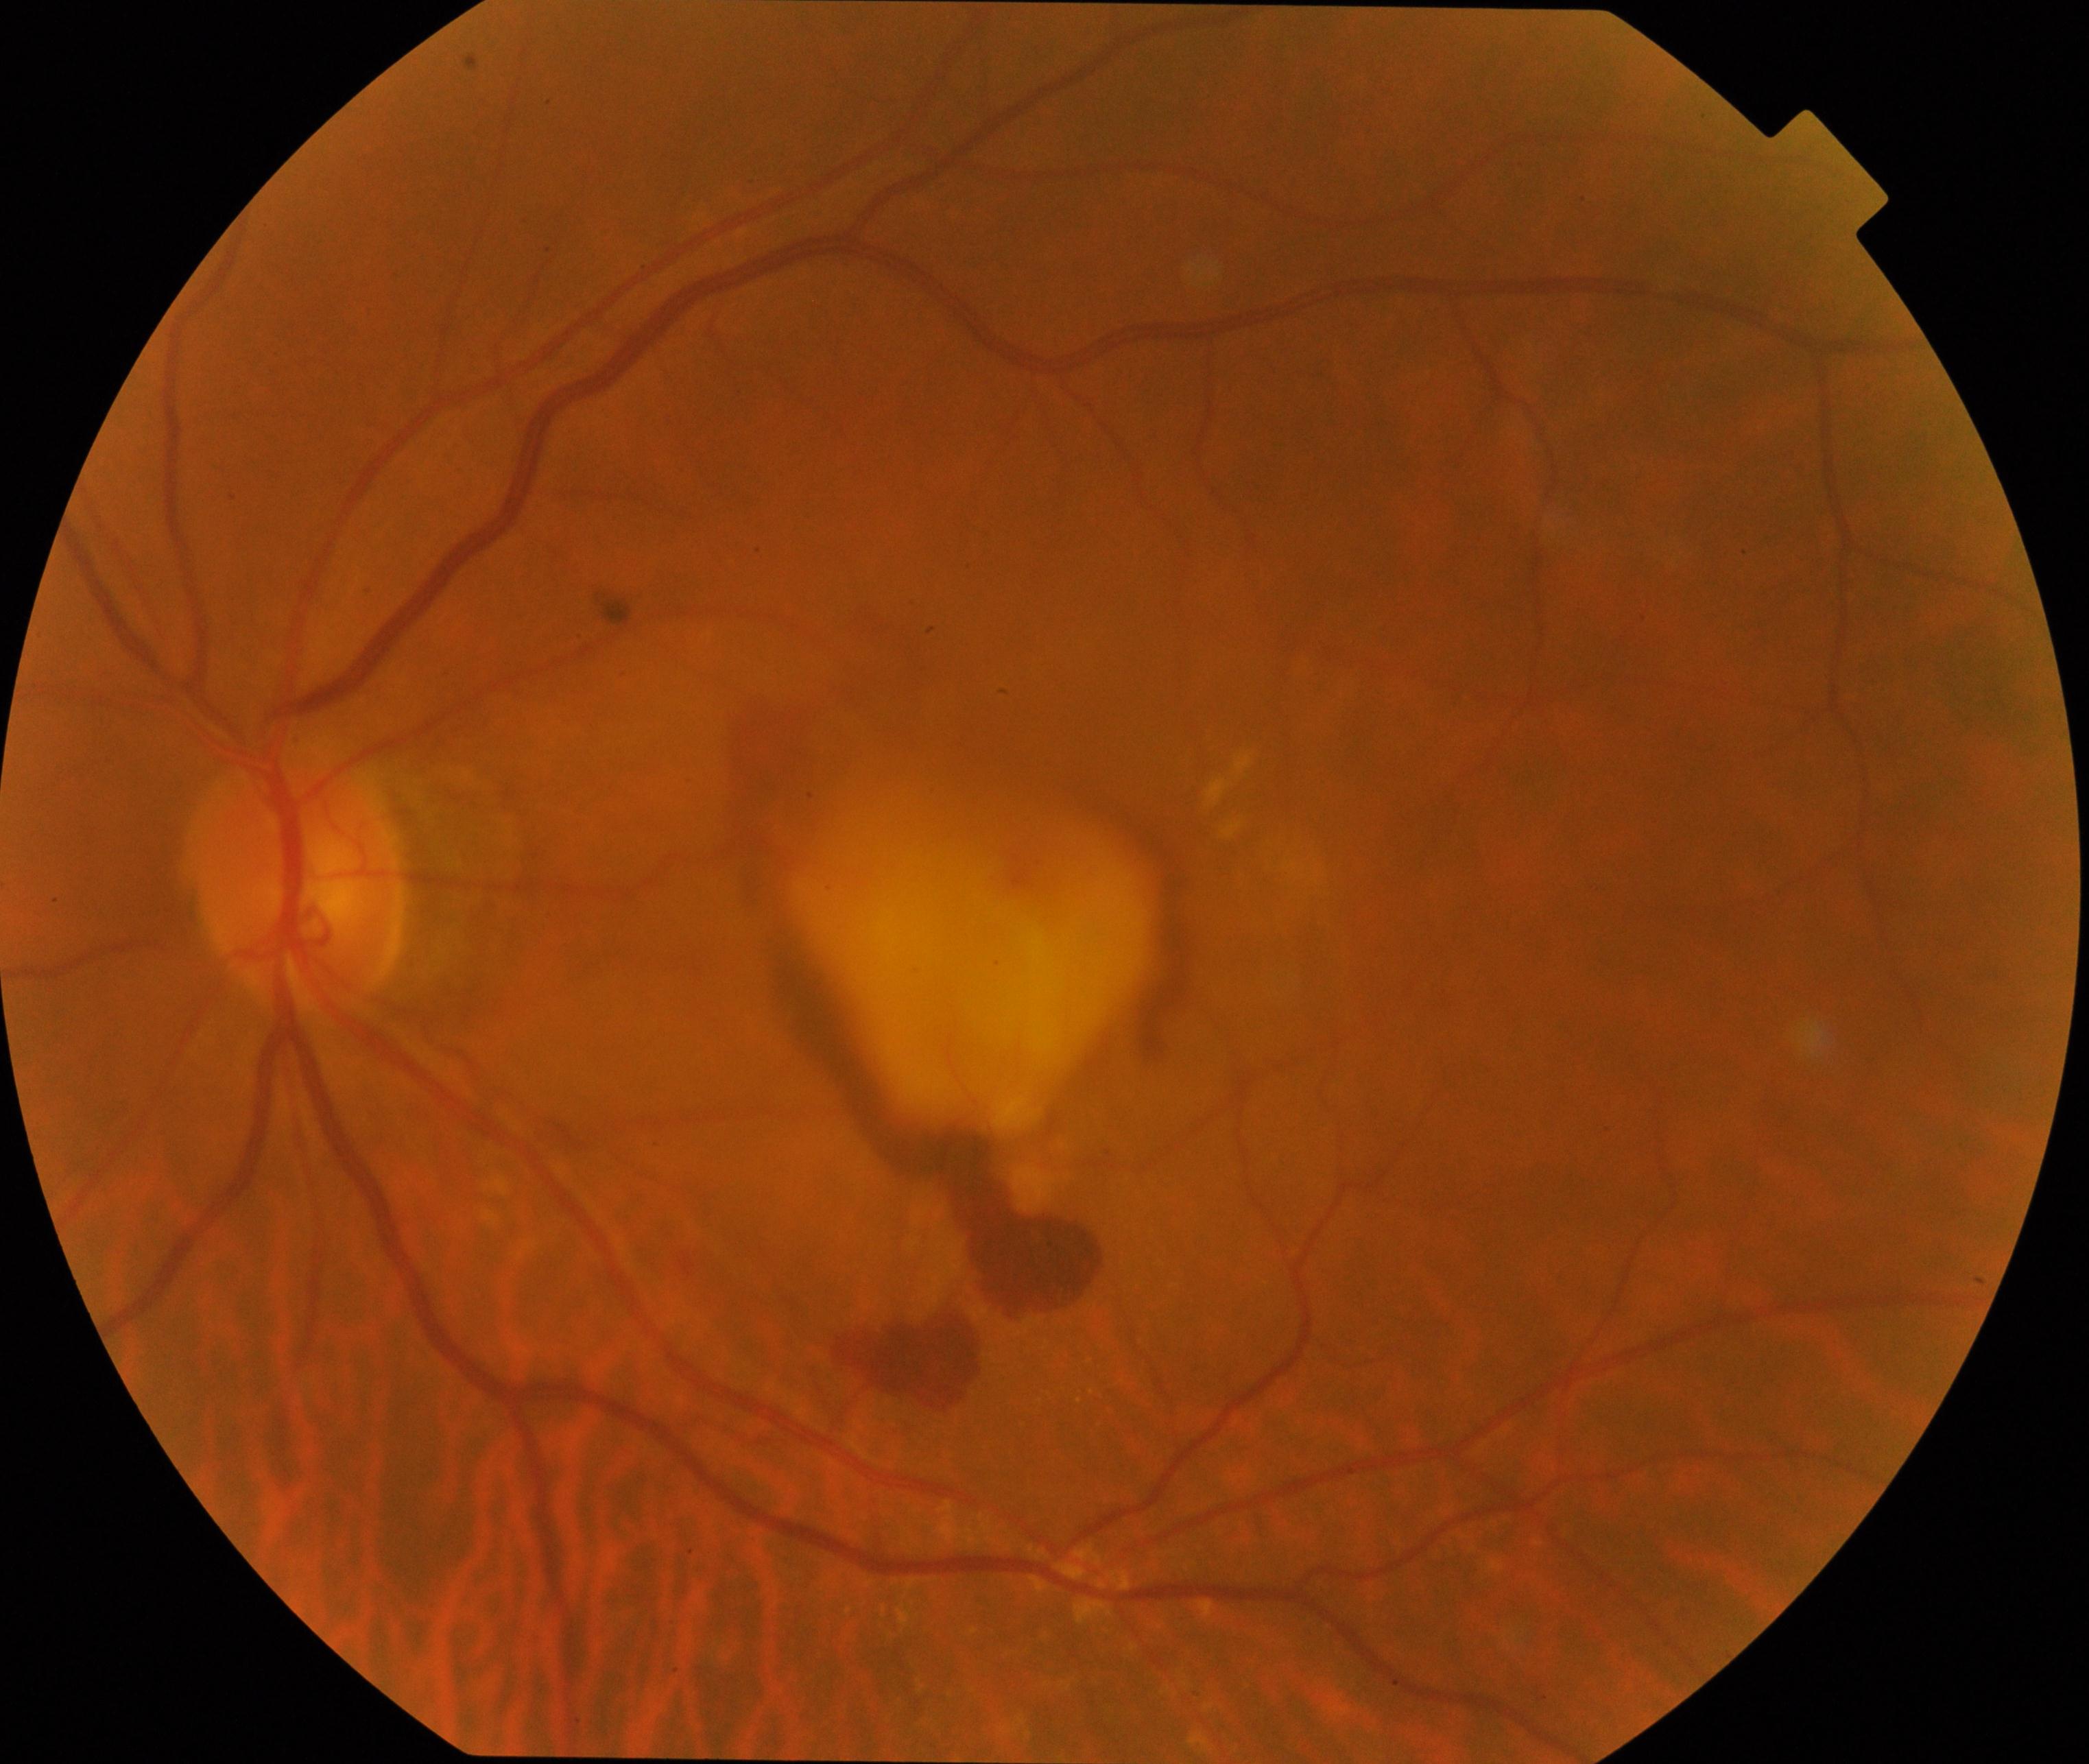
Classification: maculopathy.